240x240px; captured without pupil dilation — 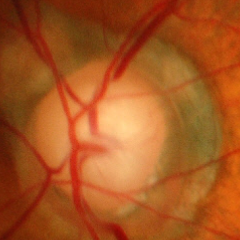

Glaucomatous changes are present. Fundus image with findings of advanced-stage glaucoma.